FOV: 50 degrees:
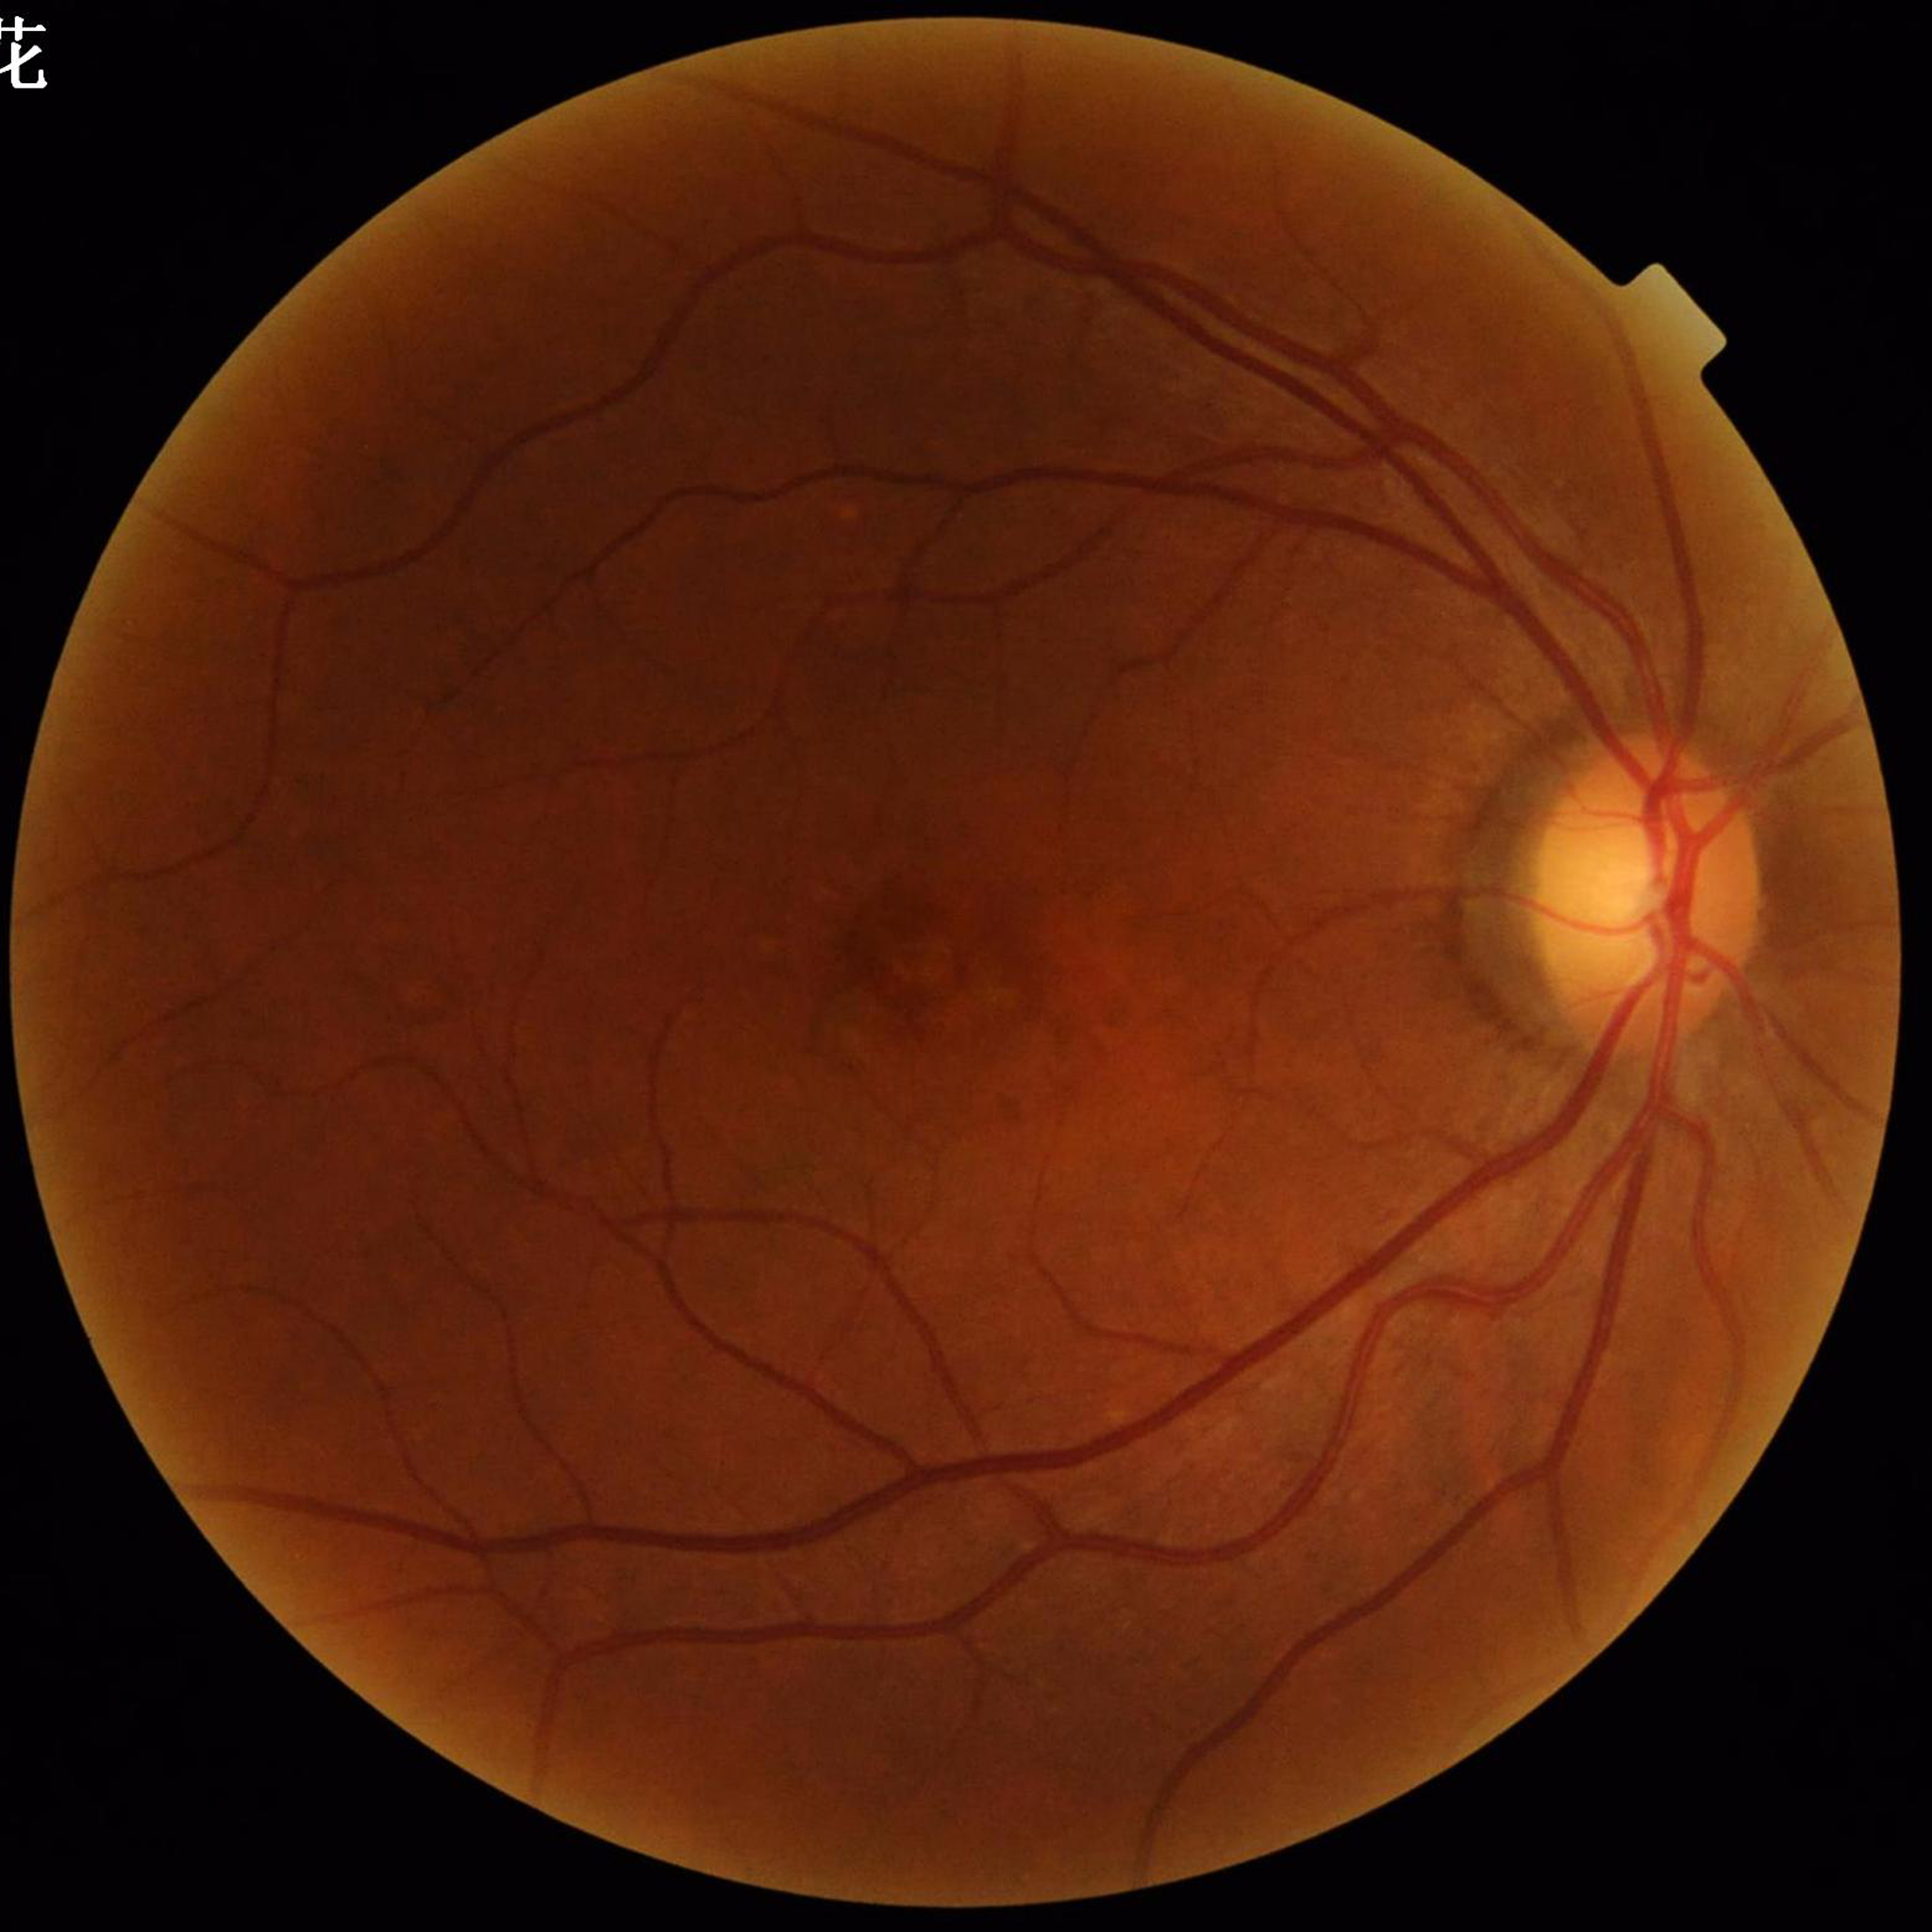 Eye affected by age-related macular degeneration (AMD). Quality: satisfactory.